Diabetic retinopathy graded by the modified Davis classification, 45-degree field of view, nonmydriatic fundus photograph — 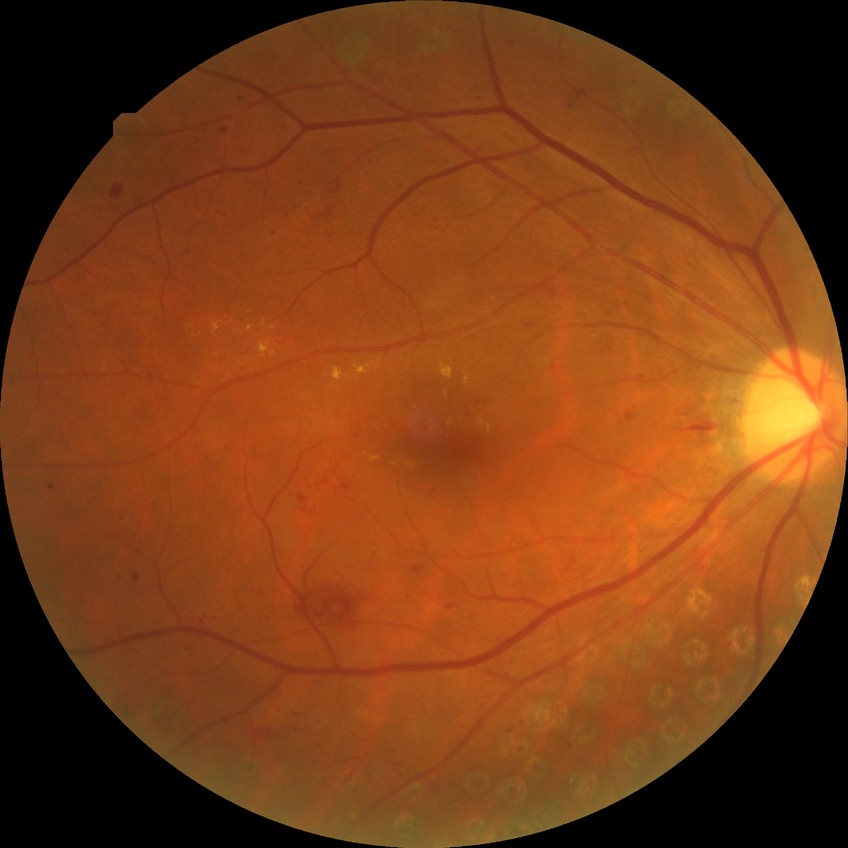 Davis stage@PPDR.